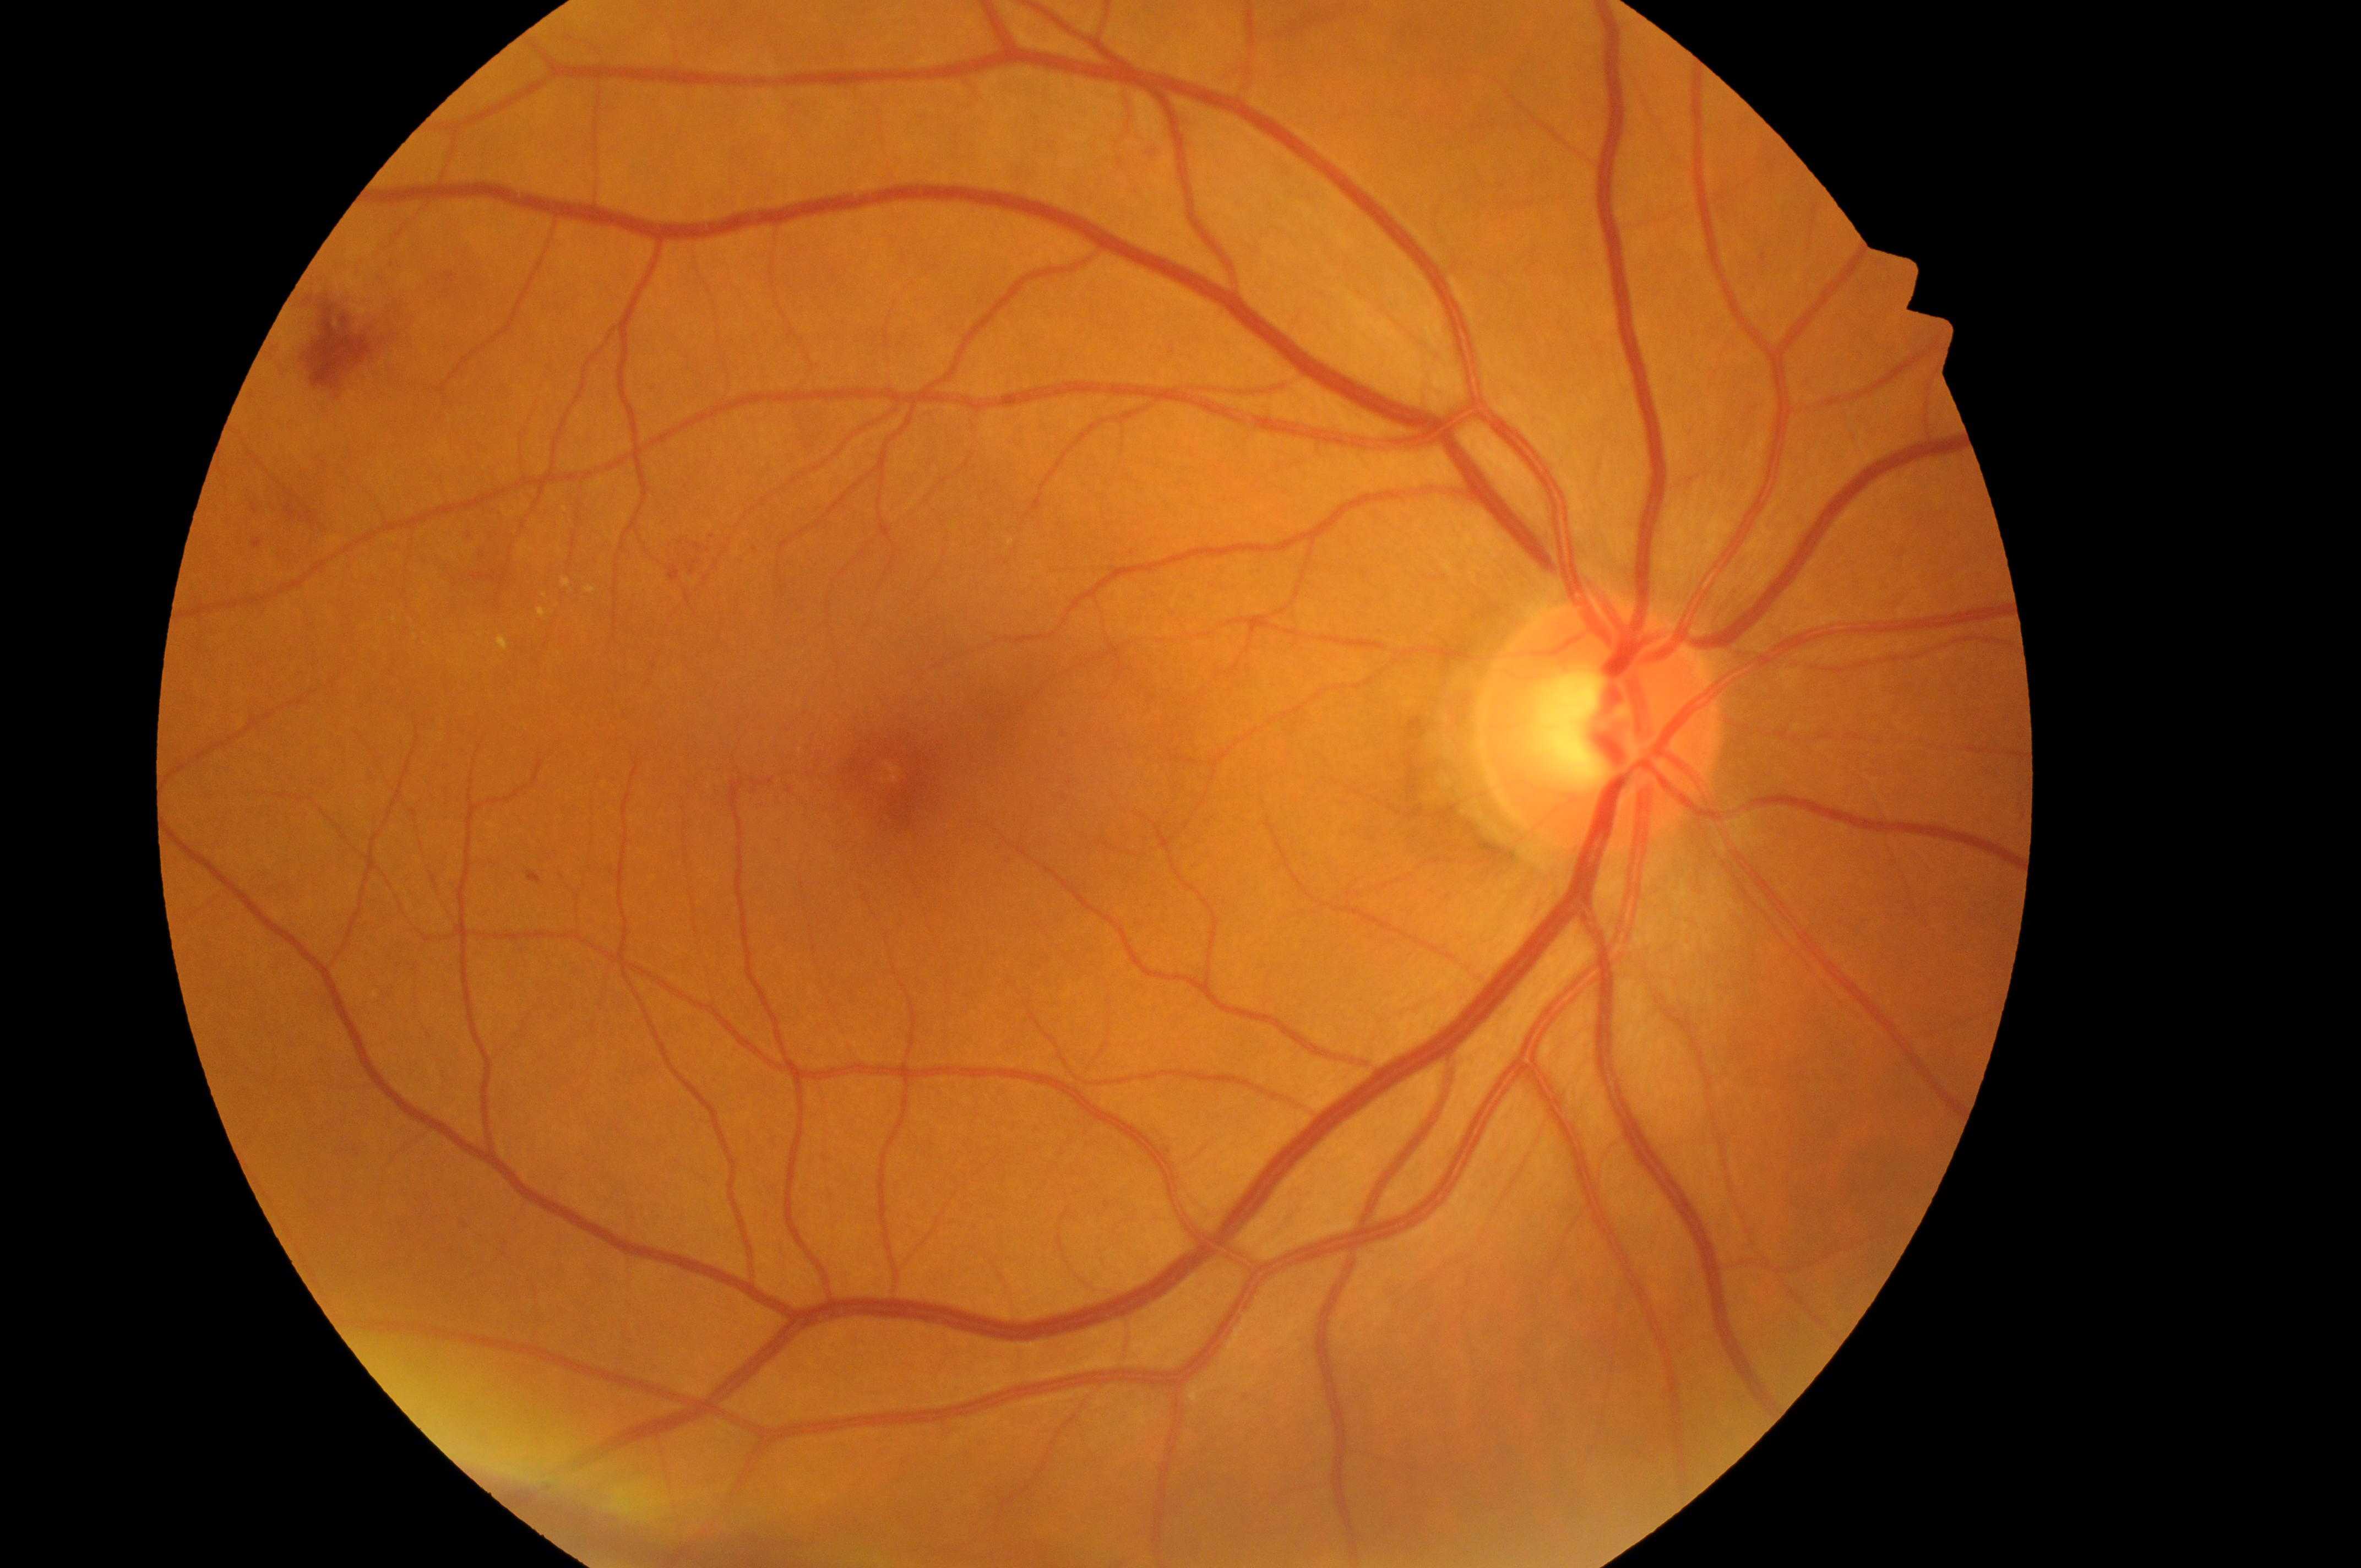

| field | value |
|---|---|
| DME grade | 1 |
| laterality | oculus dexter |
| optic disc | 1597, 734 |
| fovea center | 889, 777 |
| DR | 2/4 |